Image size 2352x1568
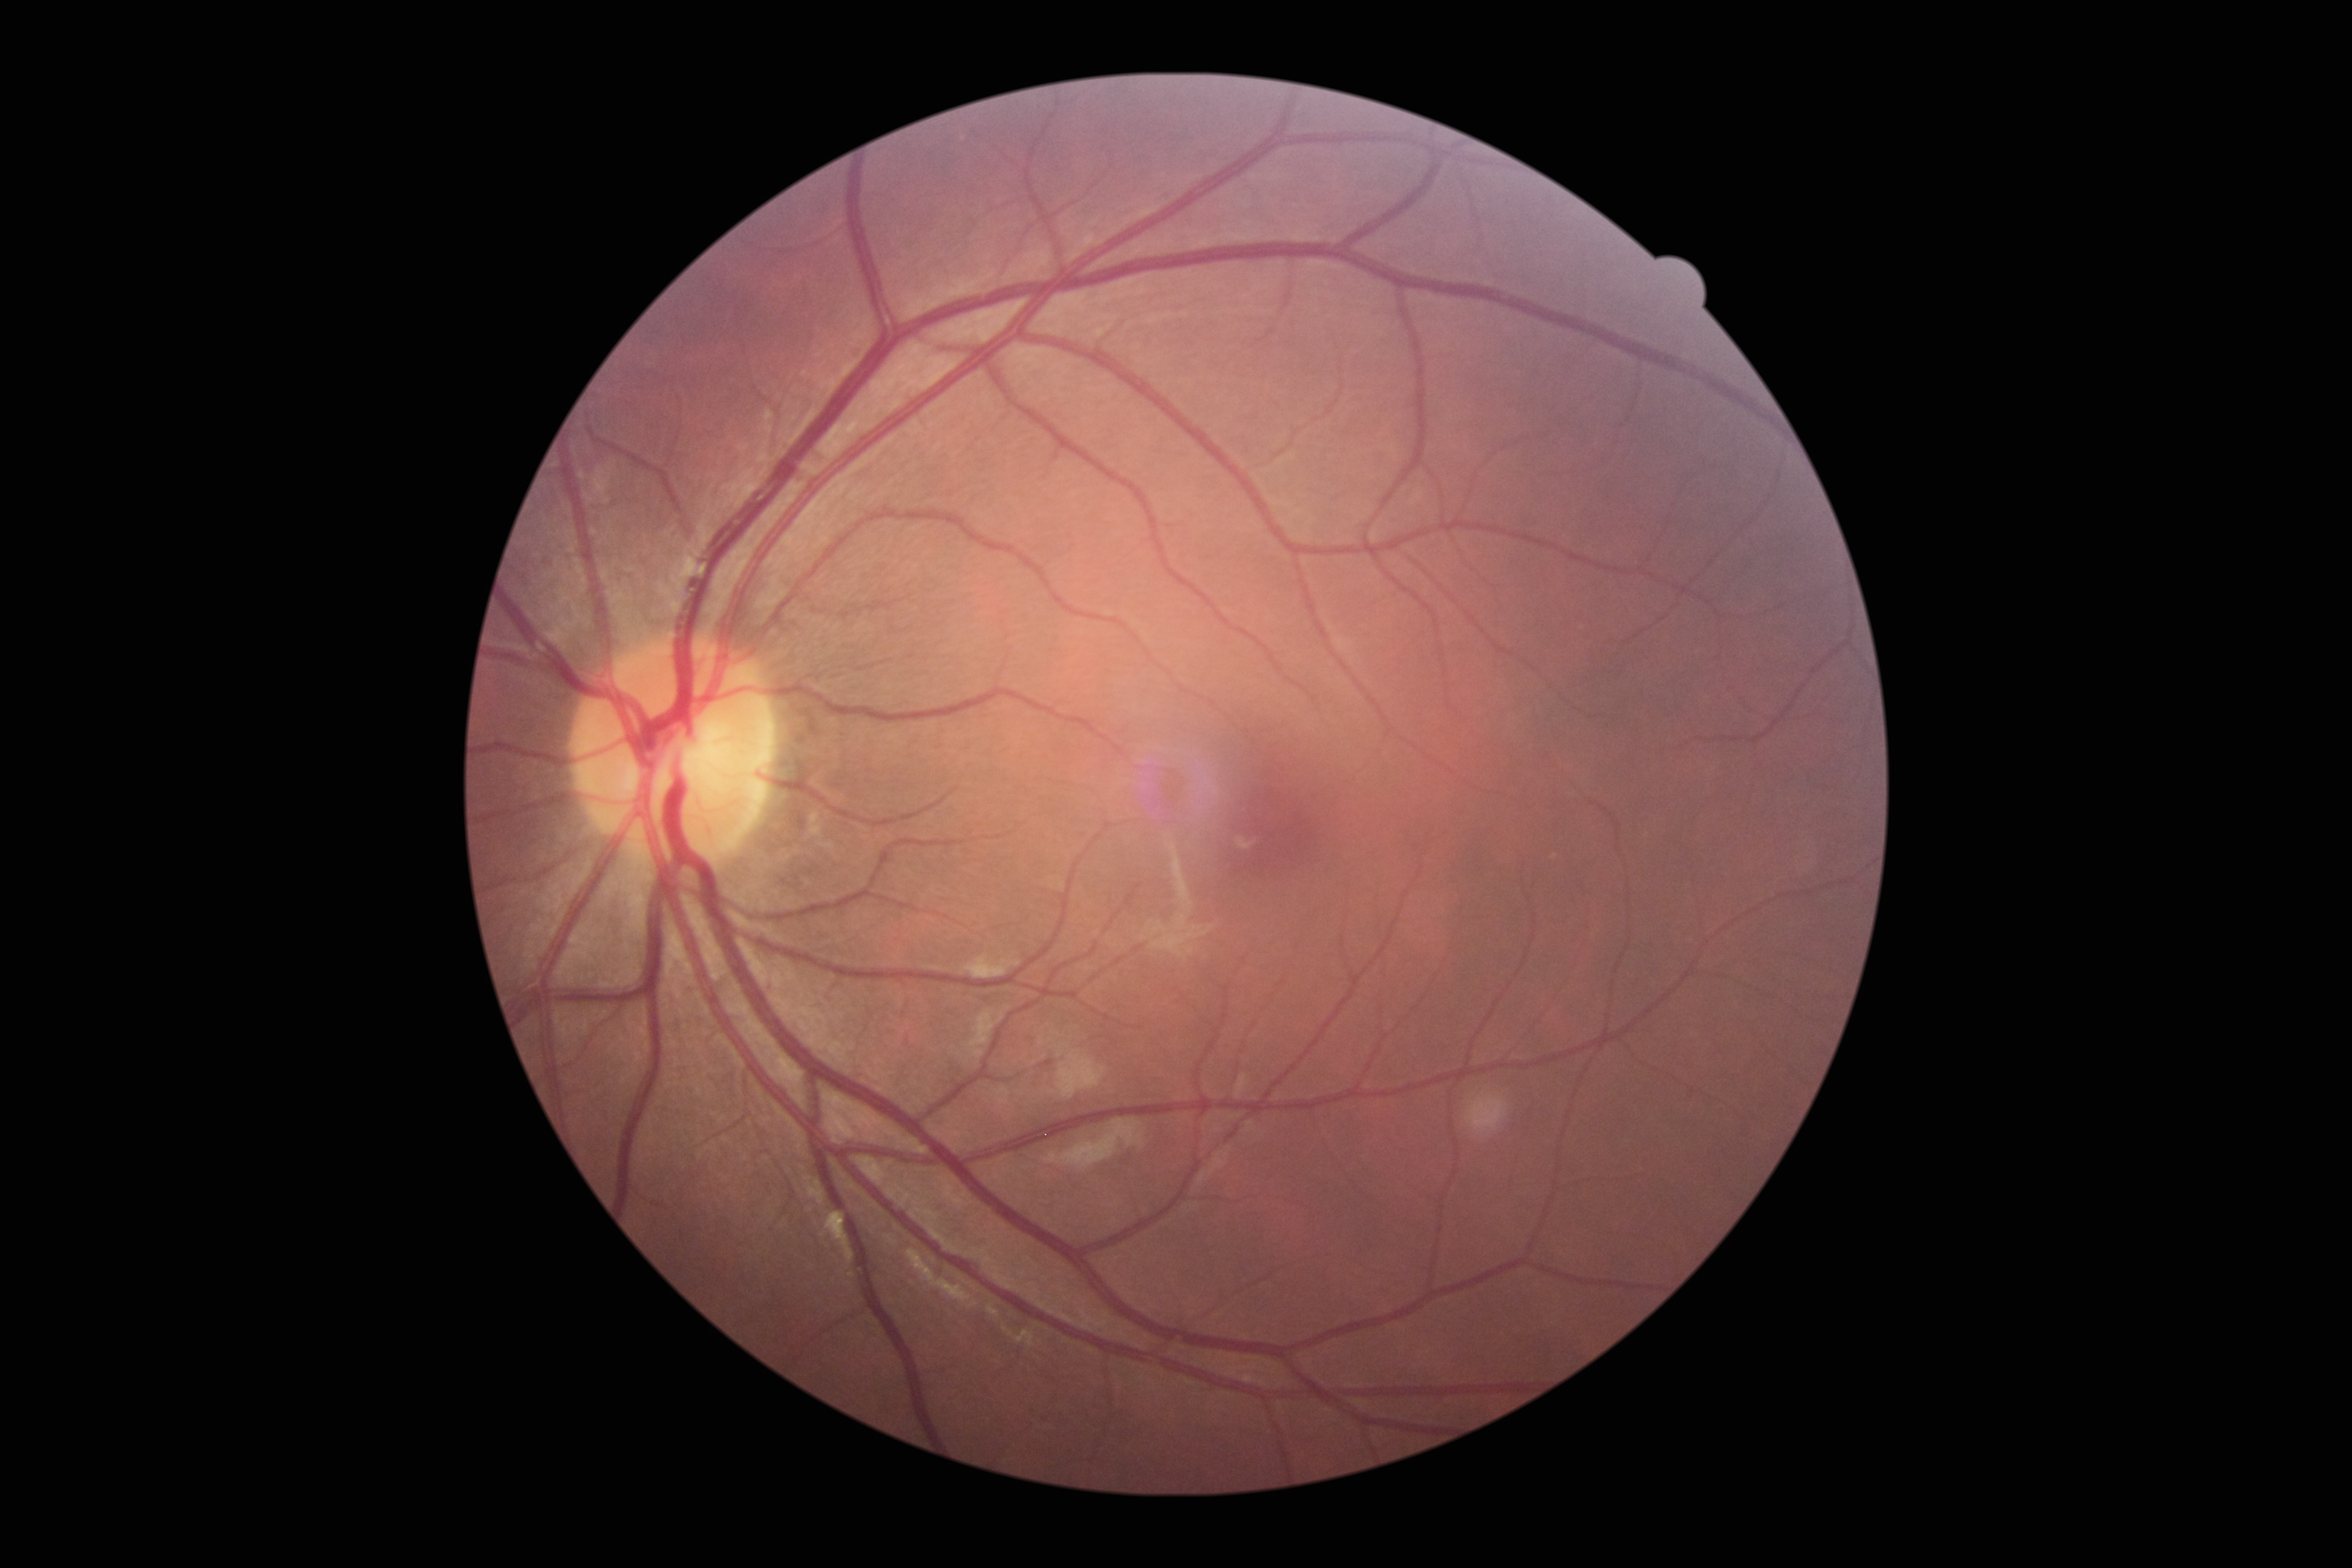

DR stage: no apparent retinopathy (grade 0).